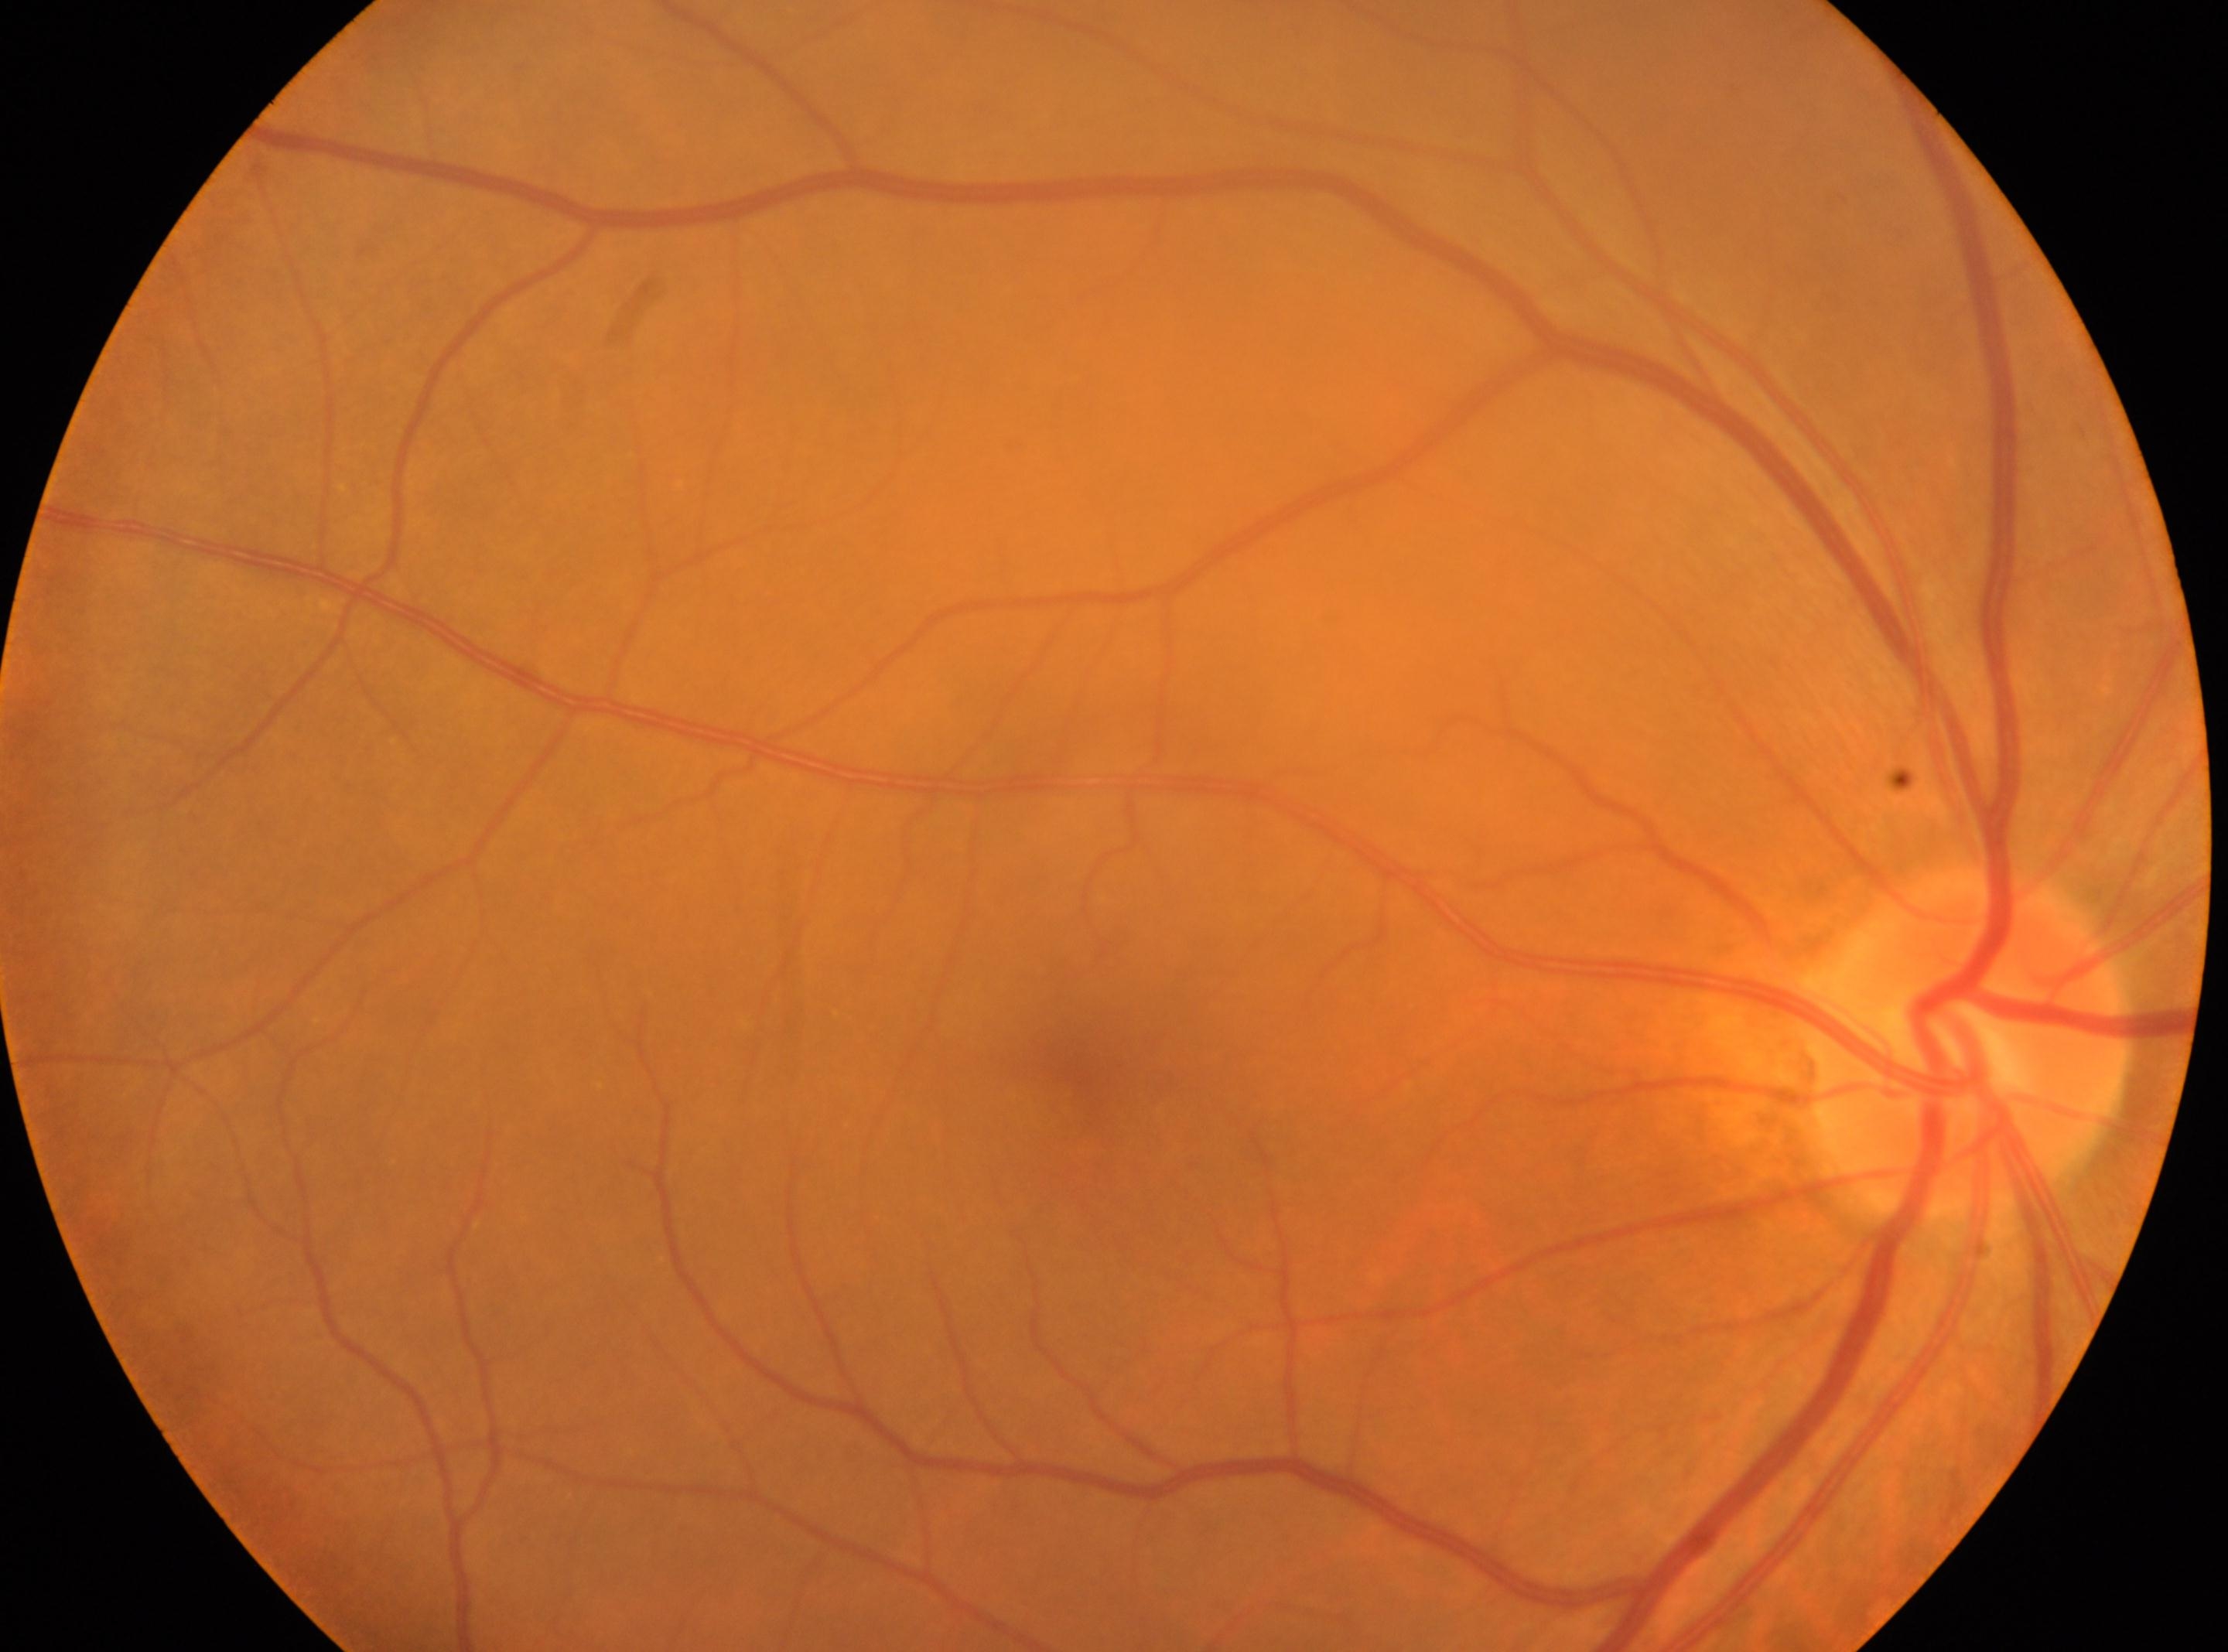 Optic disc center: (x: 1967, y: 1039).
The macula center is at (x: 1080, y: 1077).
DR grade is no apparent retinopathy (0).
Imaged eye: right.